50° FOV — 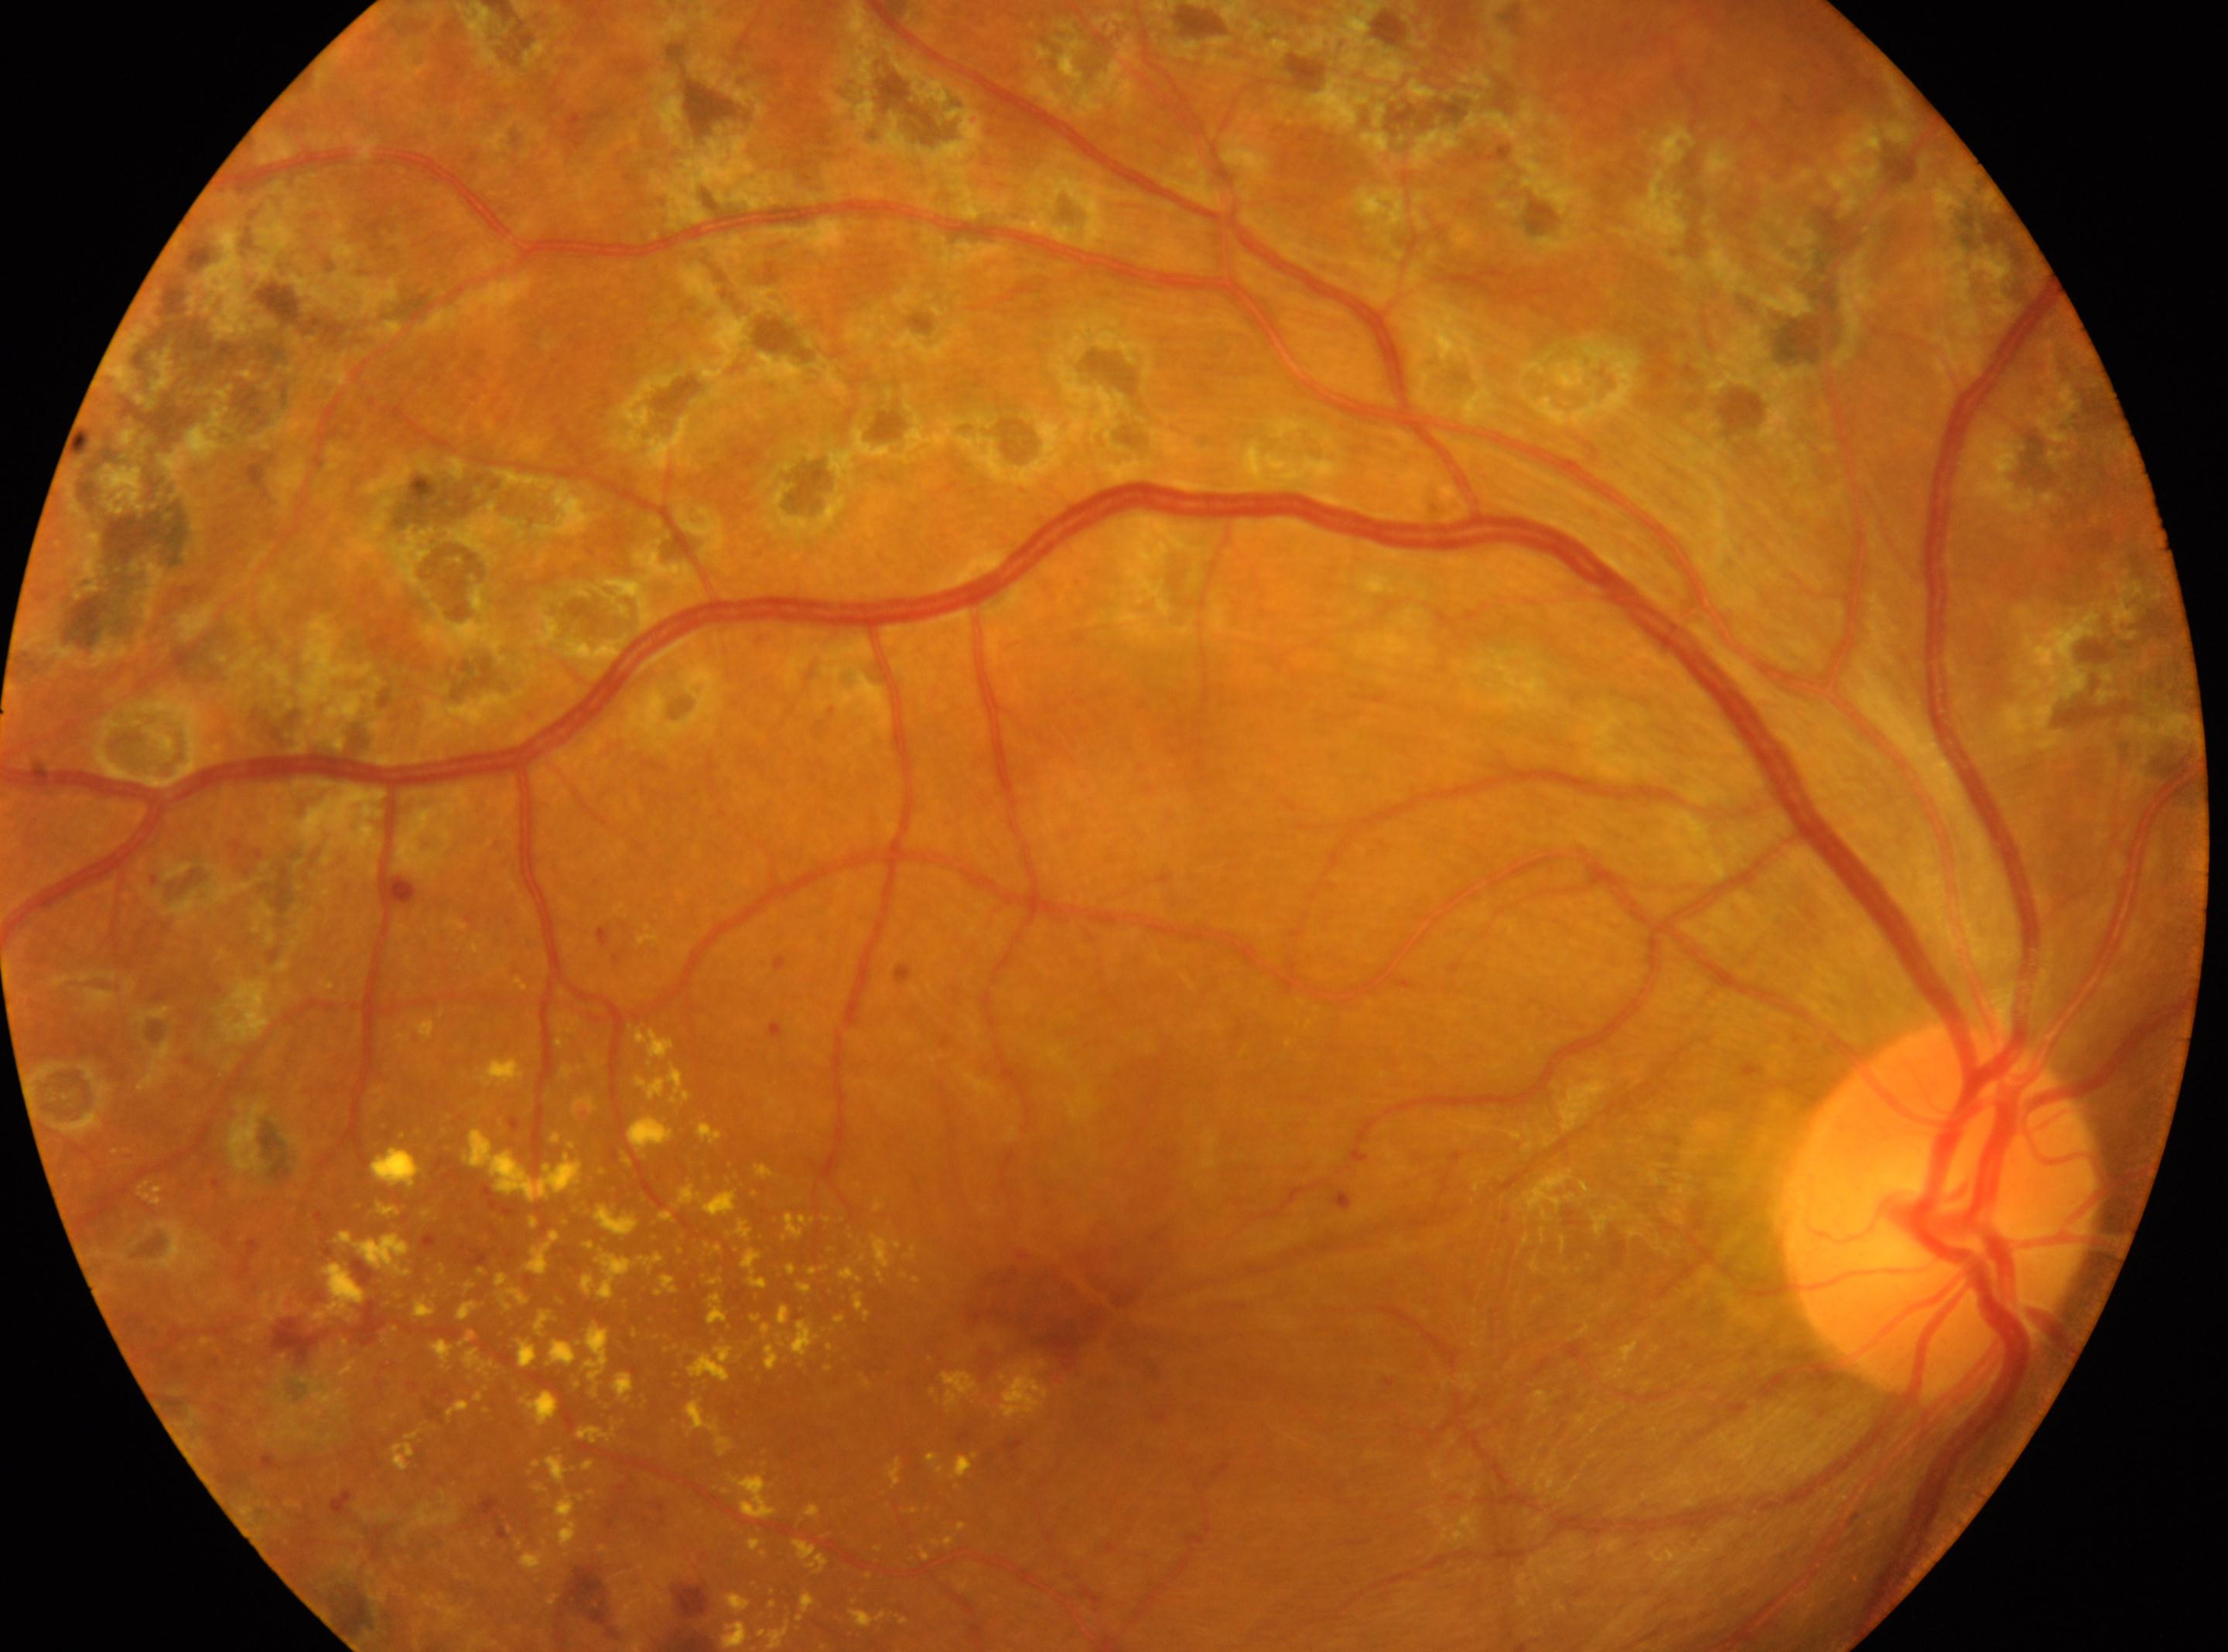
• DR severity · laser-treated DR
• foveal center · [1063, 1310]
• optic disk · [1940, 1210]
• laterality · the right eye